848x848 · nonmydriatic · CFP: 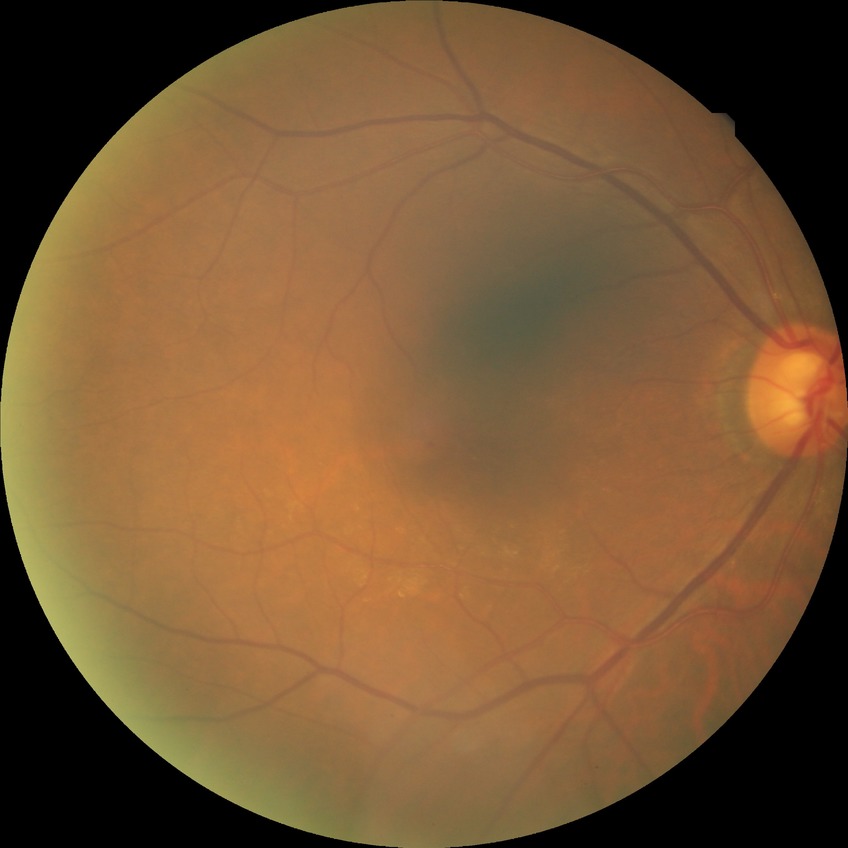
Modified Davis classification: no diabetic retinopathy.